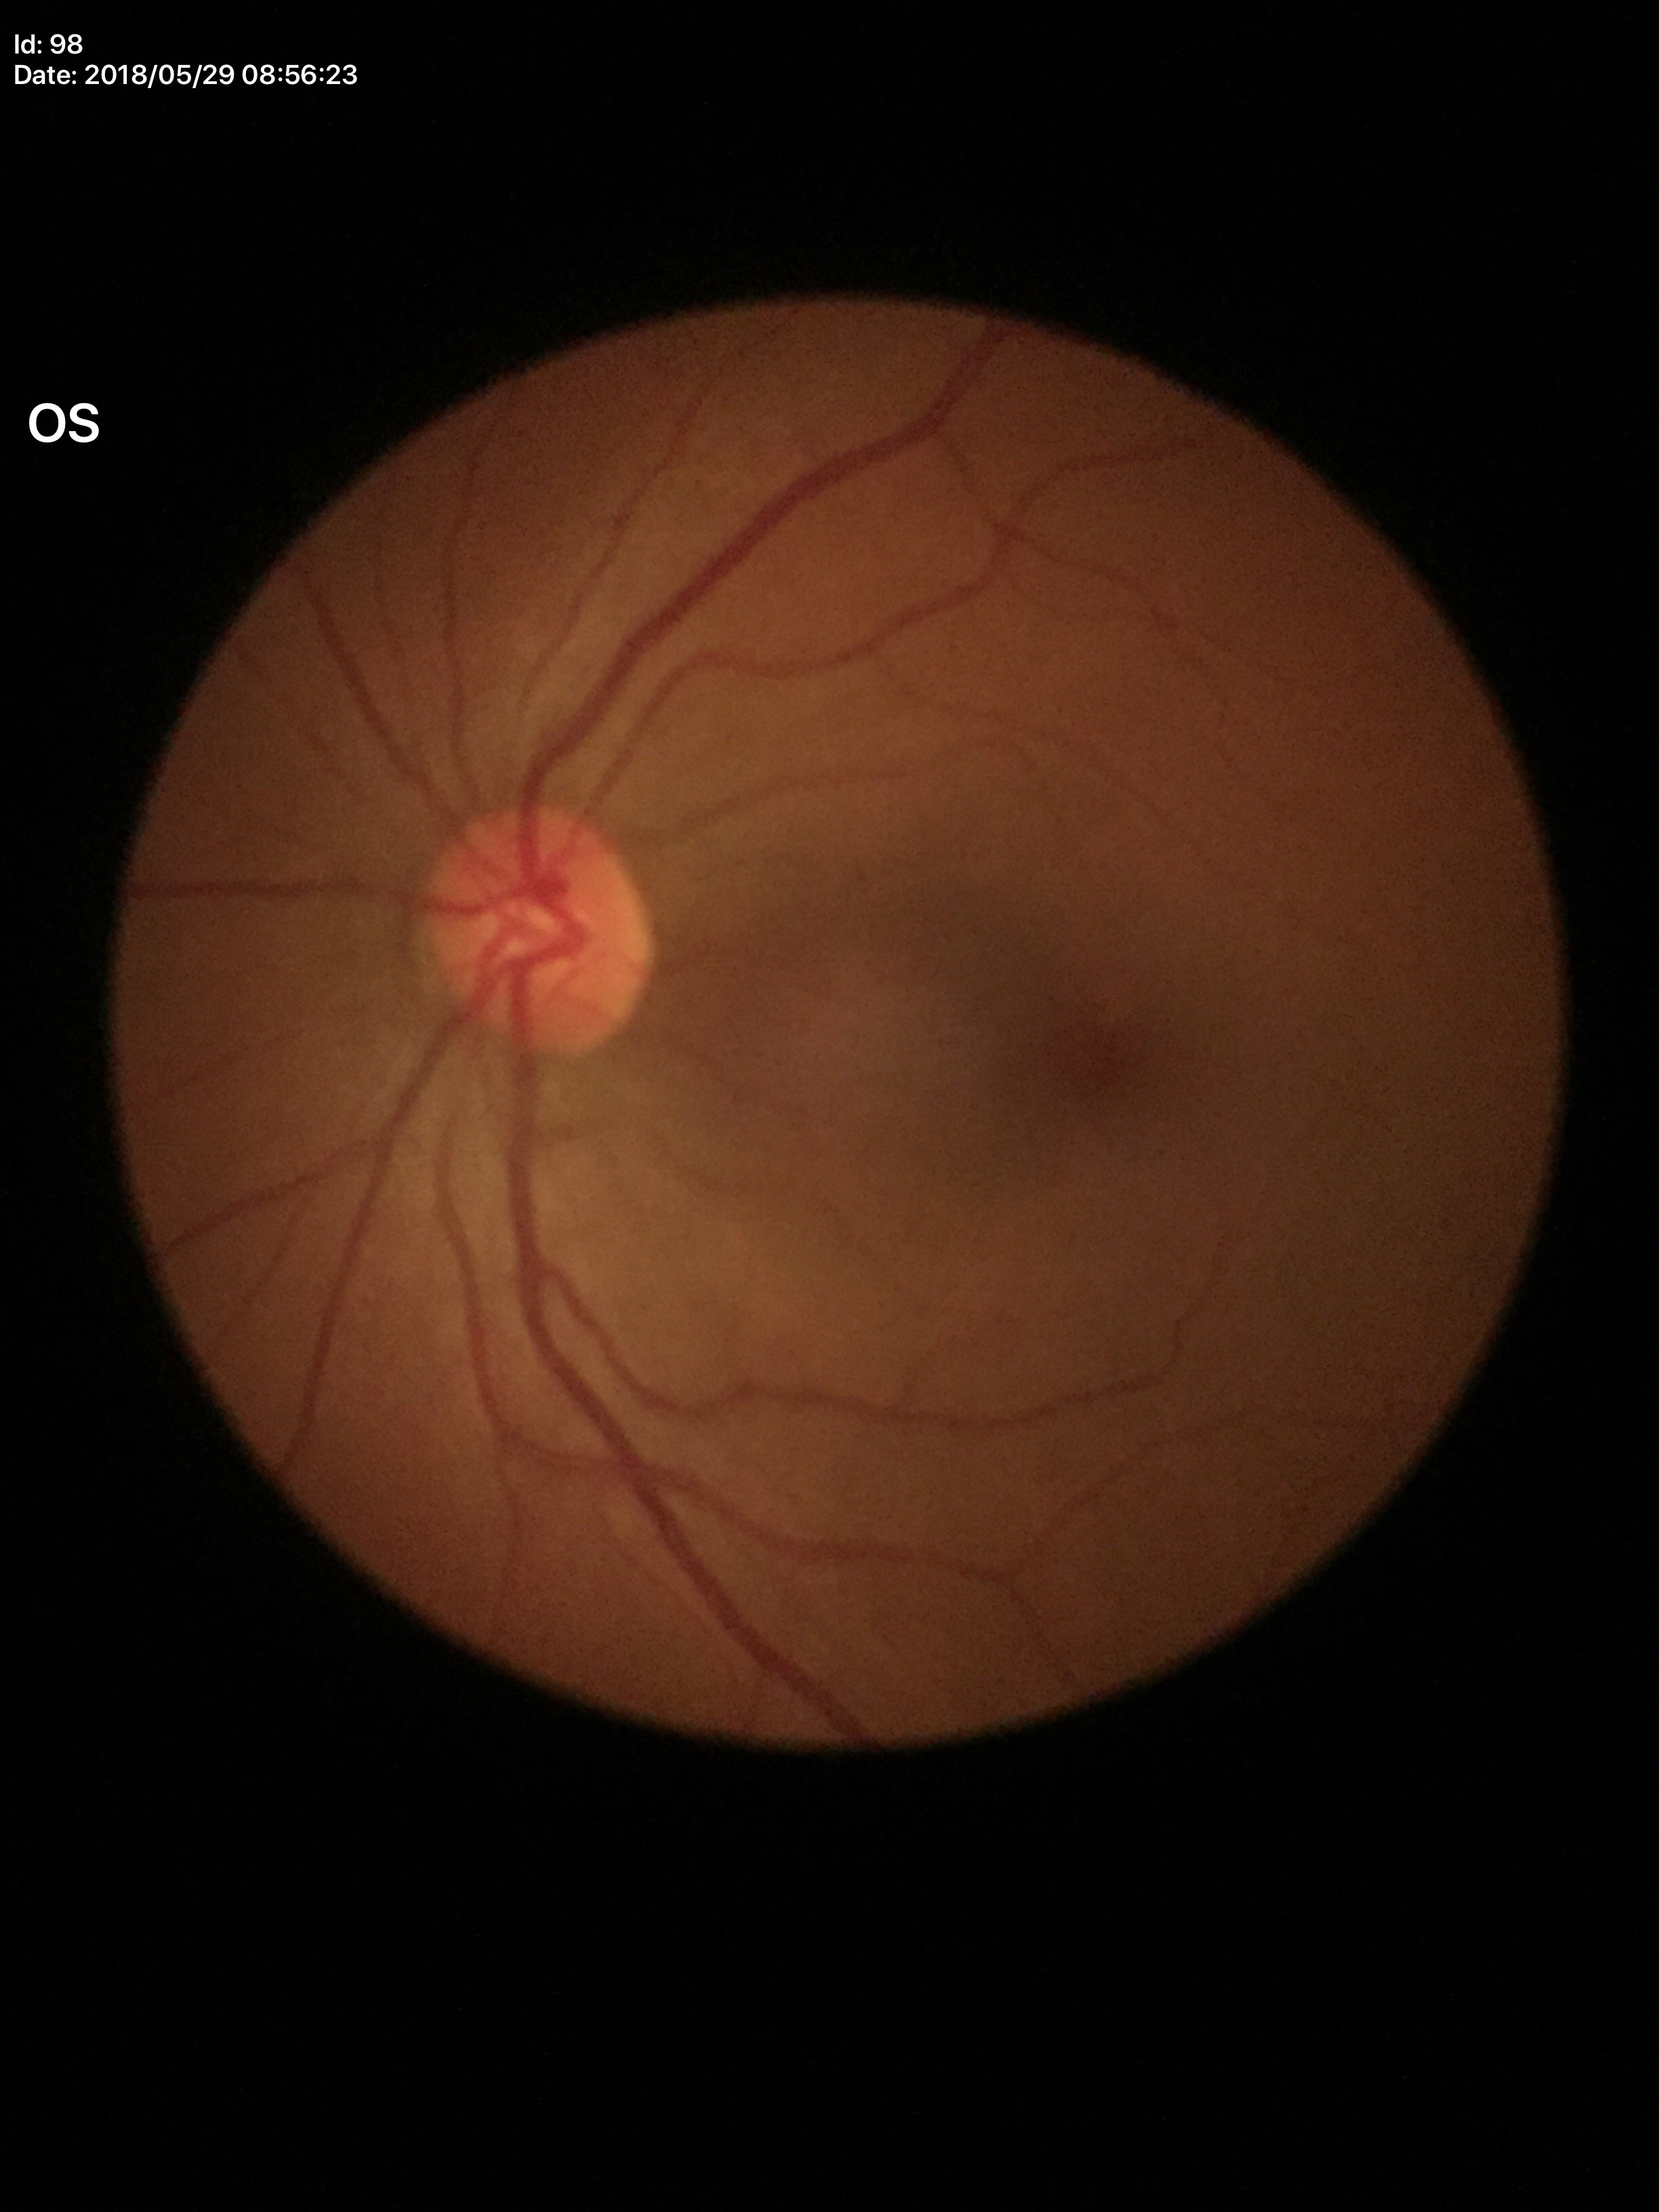
Q: What is the glaucoma assessment?
A: no suspicious findings (5/5 ophthalmologists in agreement)
Q: Vertical CDR?
A: 0.43